Pediatric retinal photograph (wide-field)
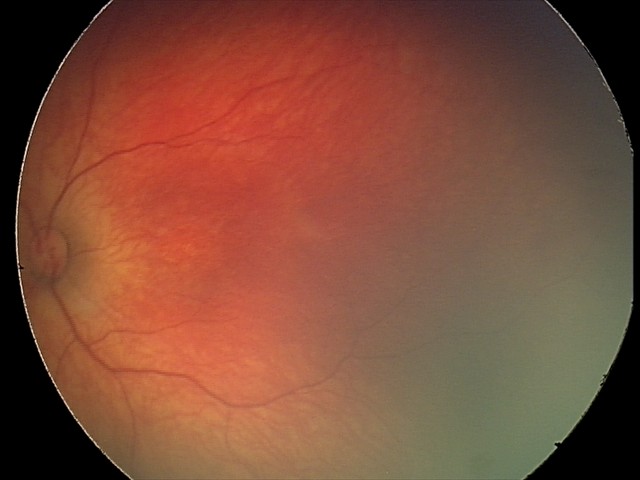
Series diagnosed as retinal hemorrhages.